FOV: 45 degrees — 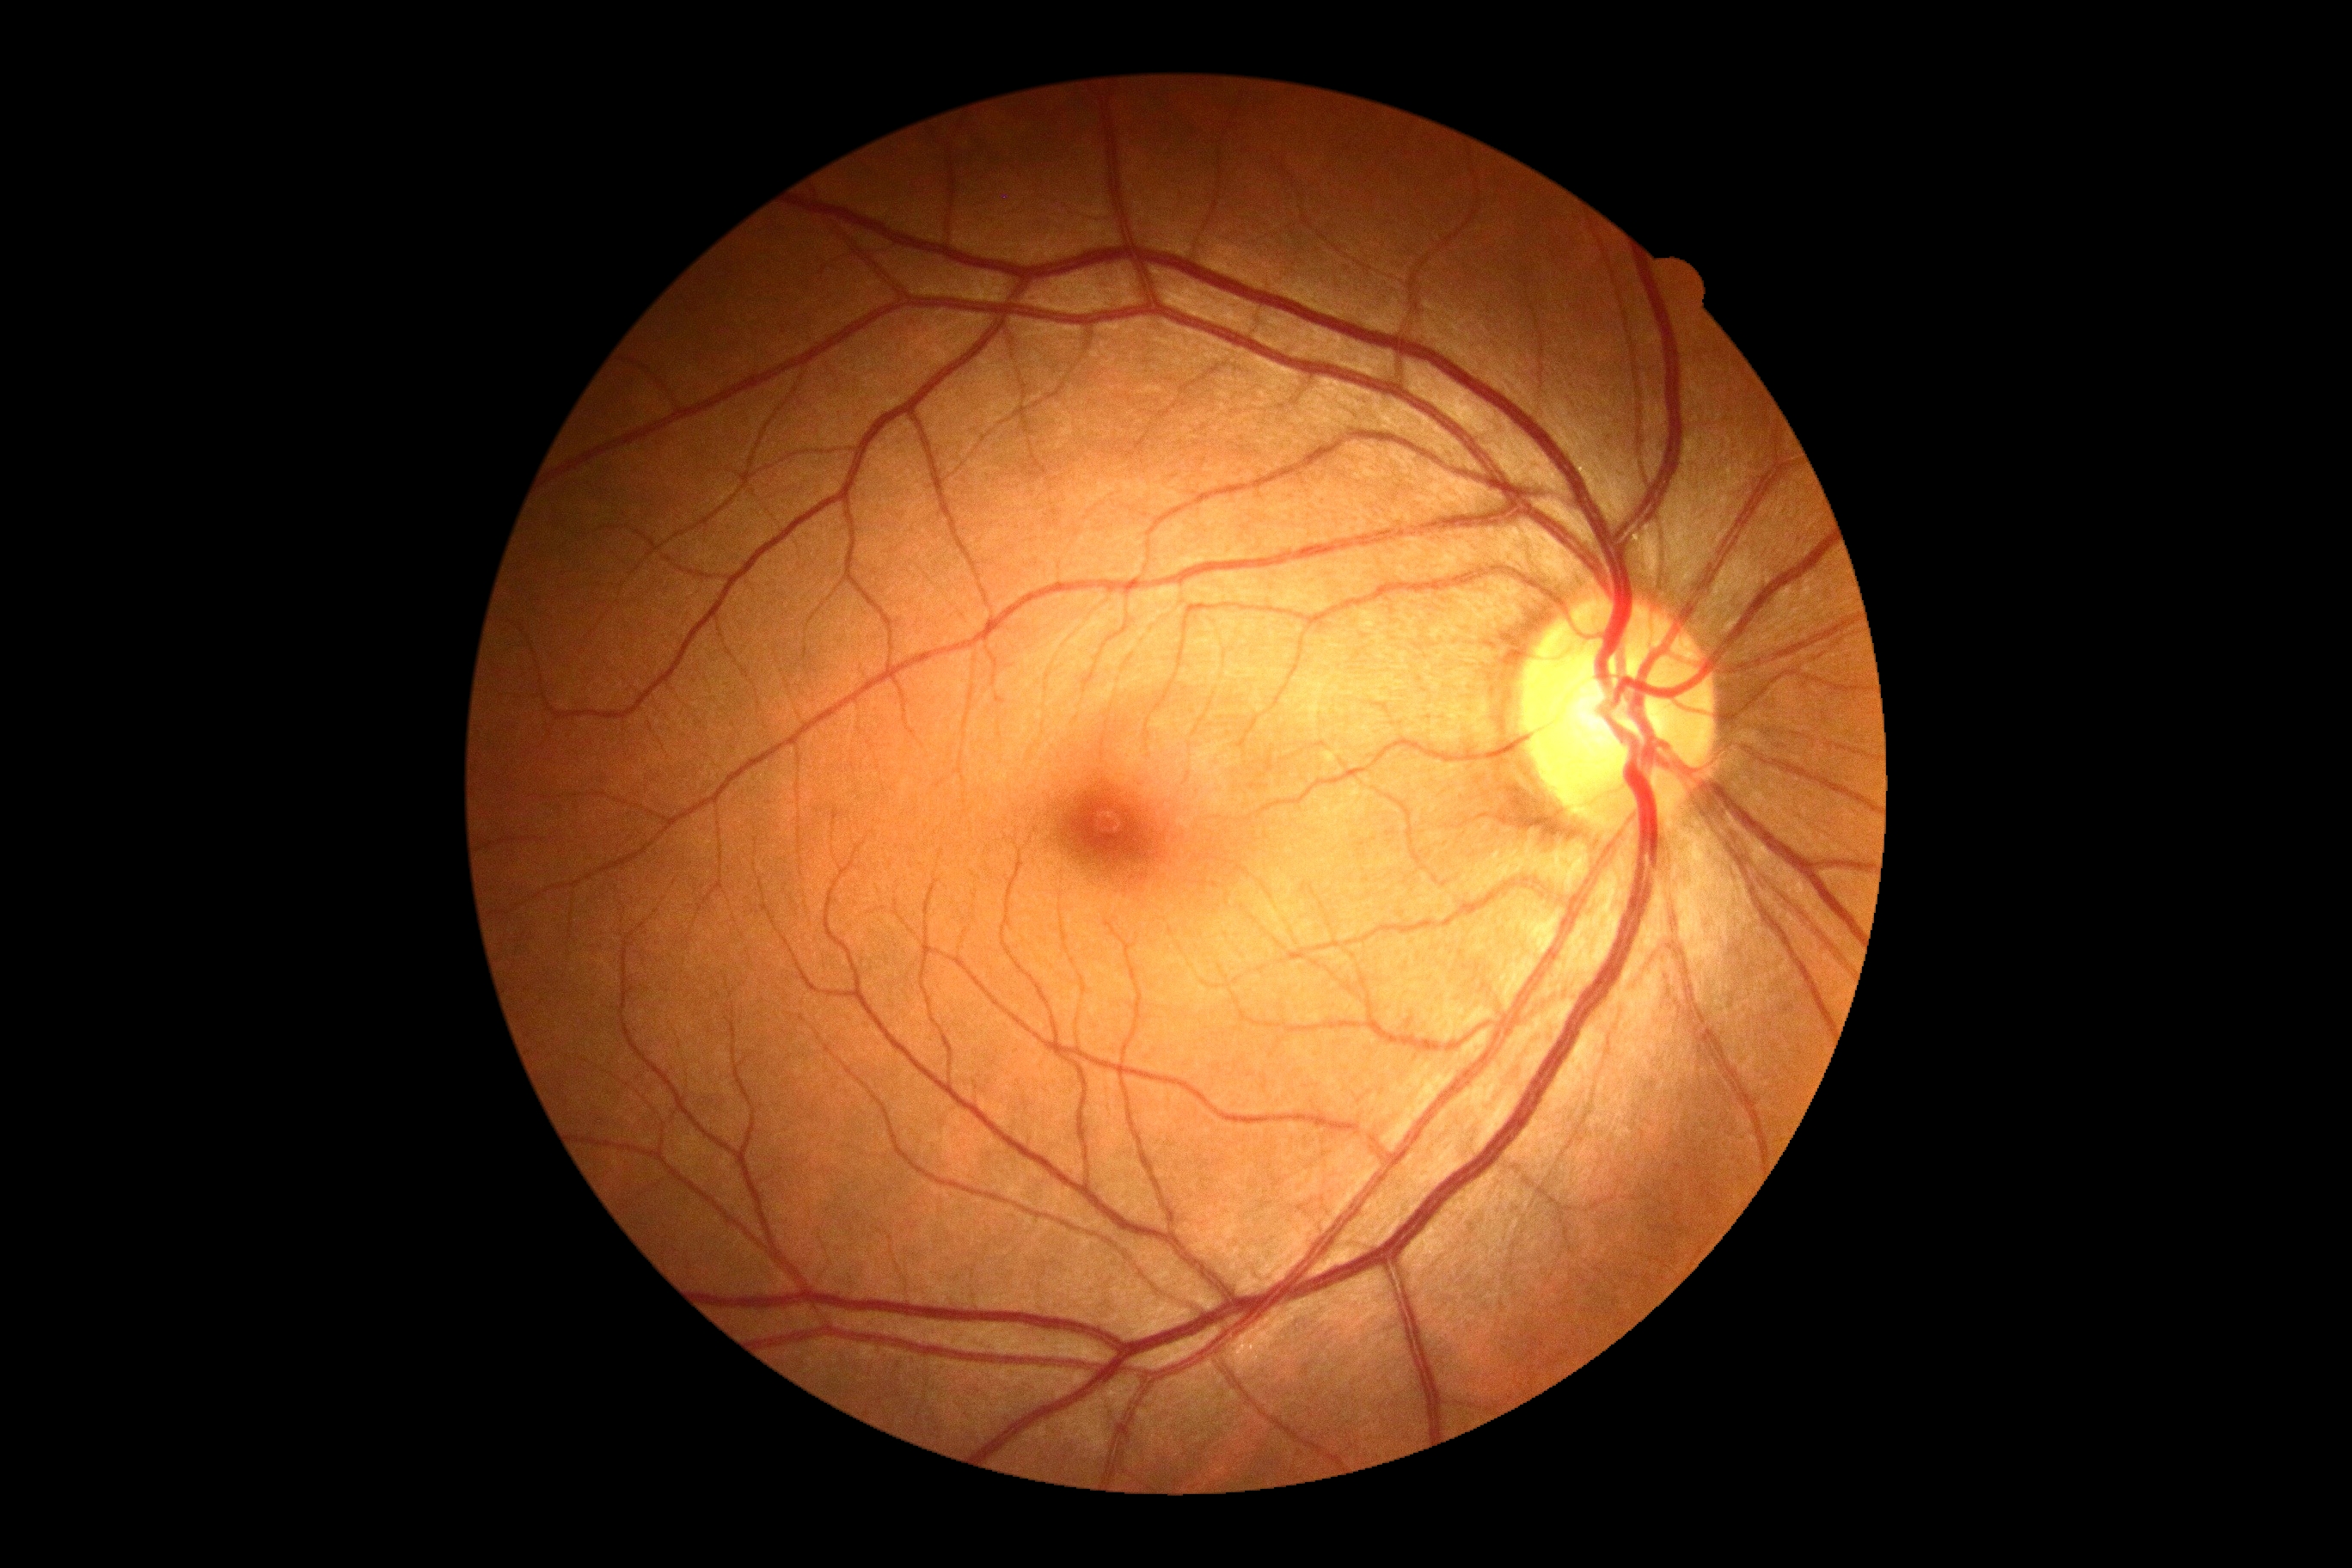

Retinopathy grade is 0.